Modified Davis grading
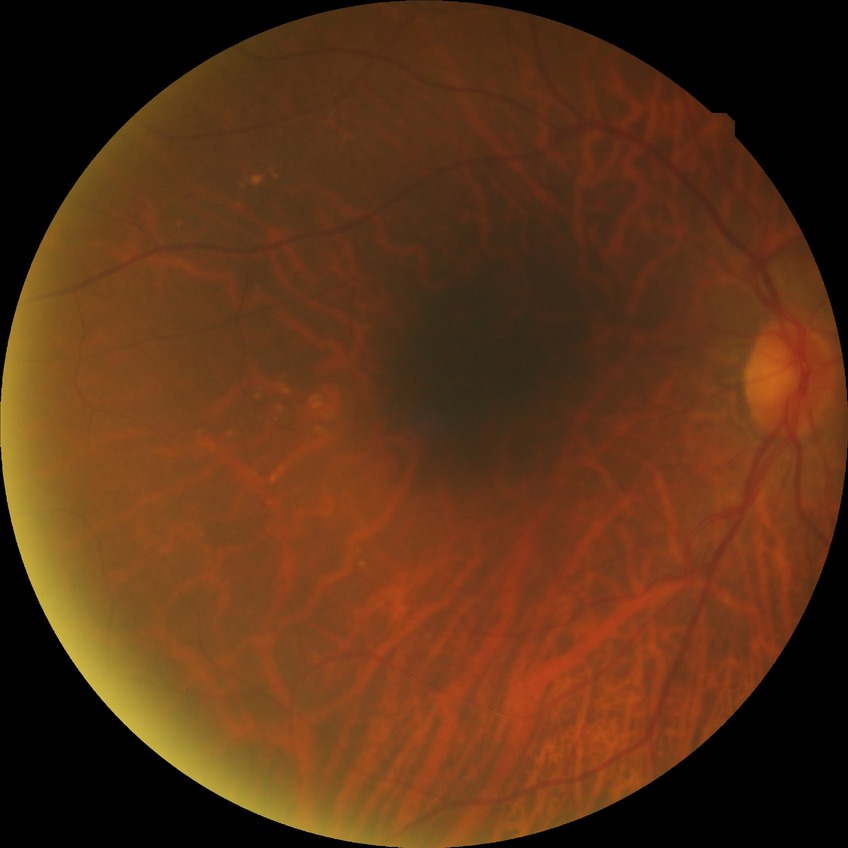
diabetic retinopathy (DR): NDR (no diabetic retinopathy).